Nonmydriatic, retinal fundus photograph, graded on the modified Davis scale, 848 x 848 pixels, camera: NIDEK AFC-230 — 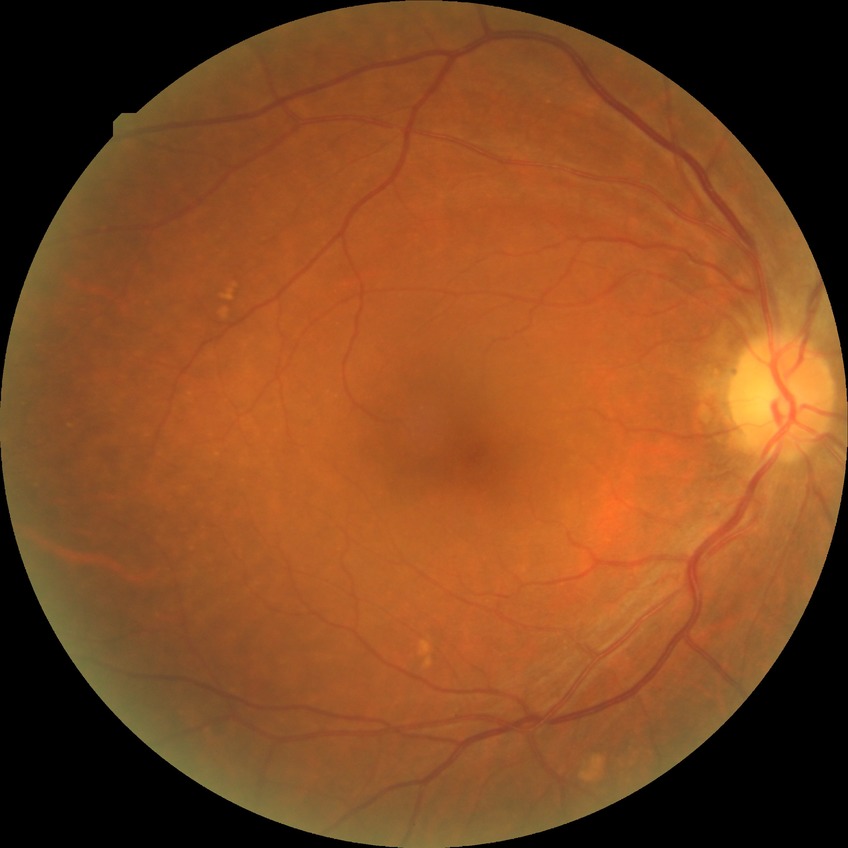 Diabetic retinopathy stage: no diabetic retinopathy.